2212 x 1672 pixels. Color fundus photograph:
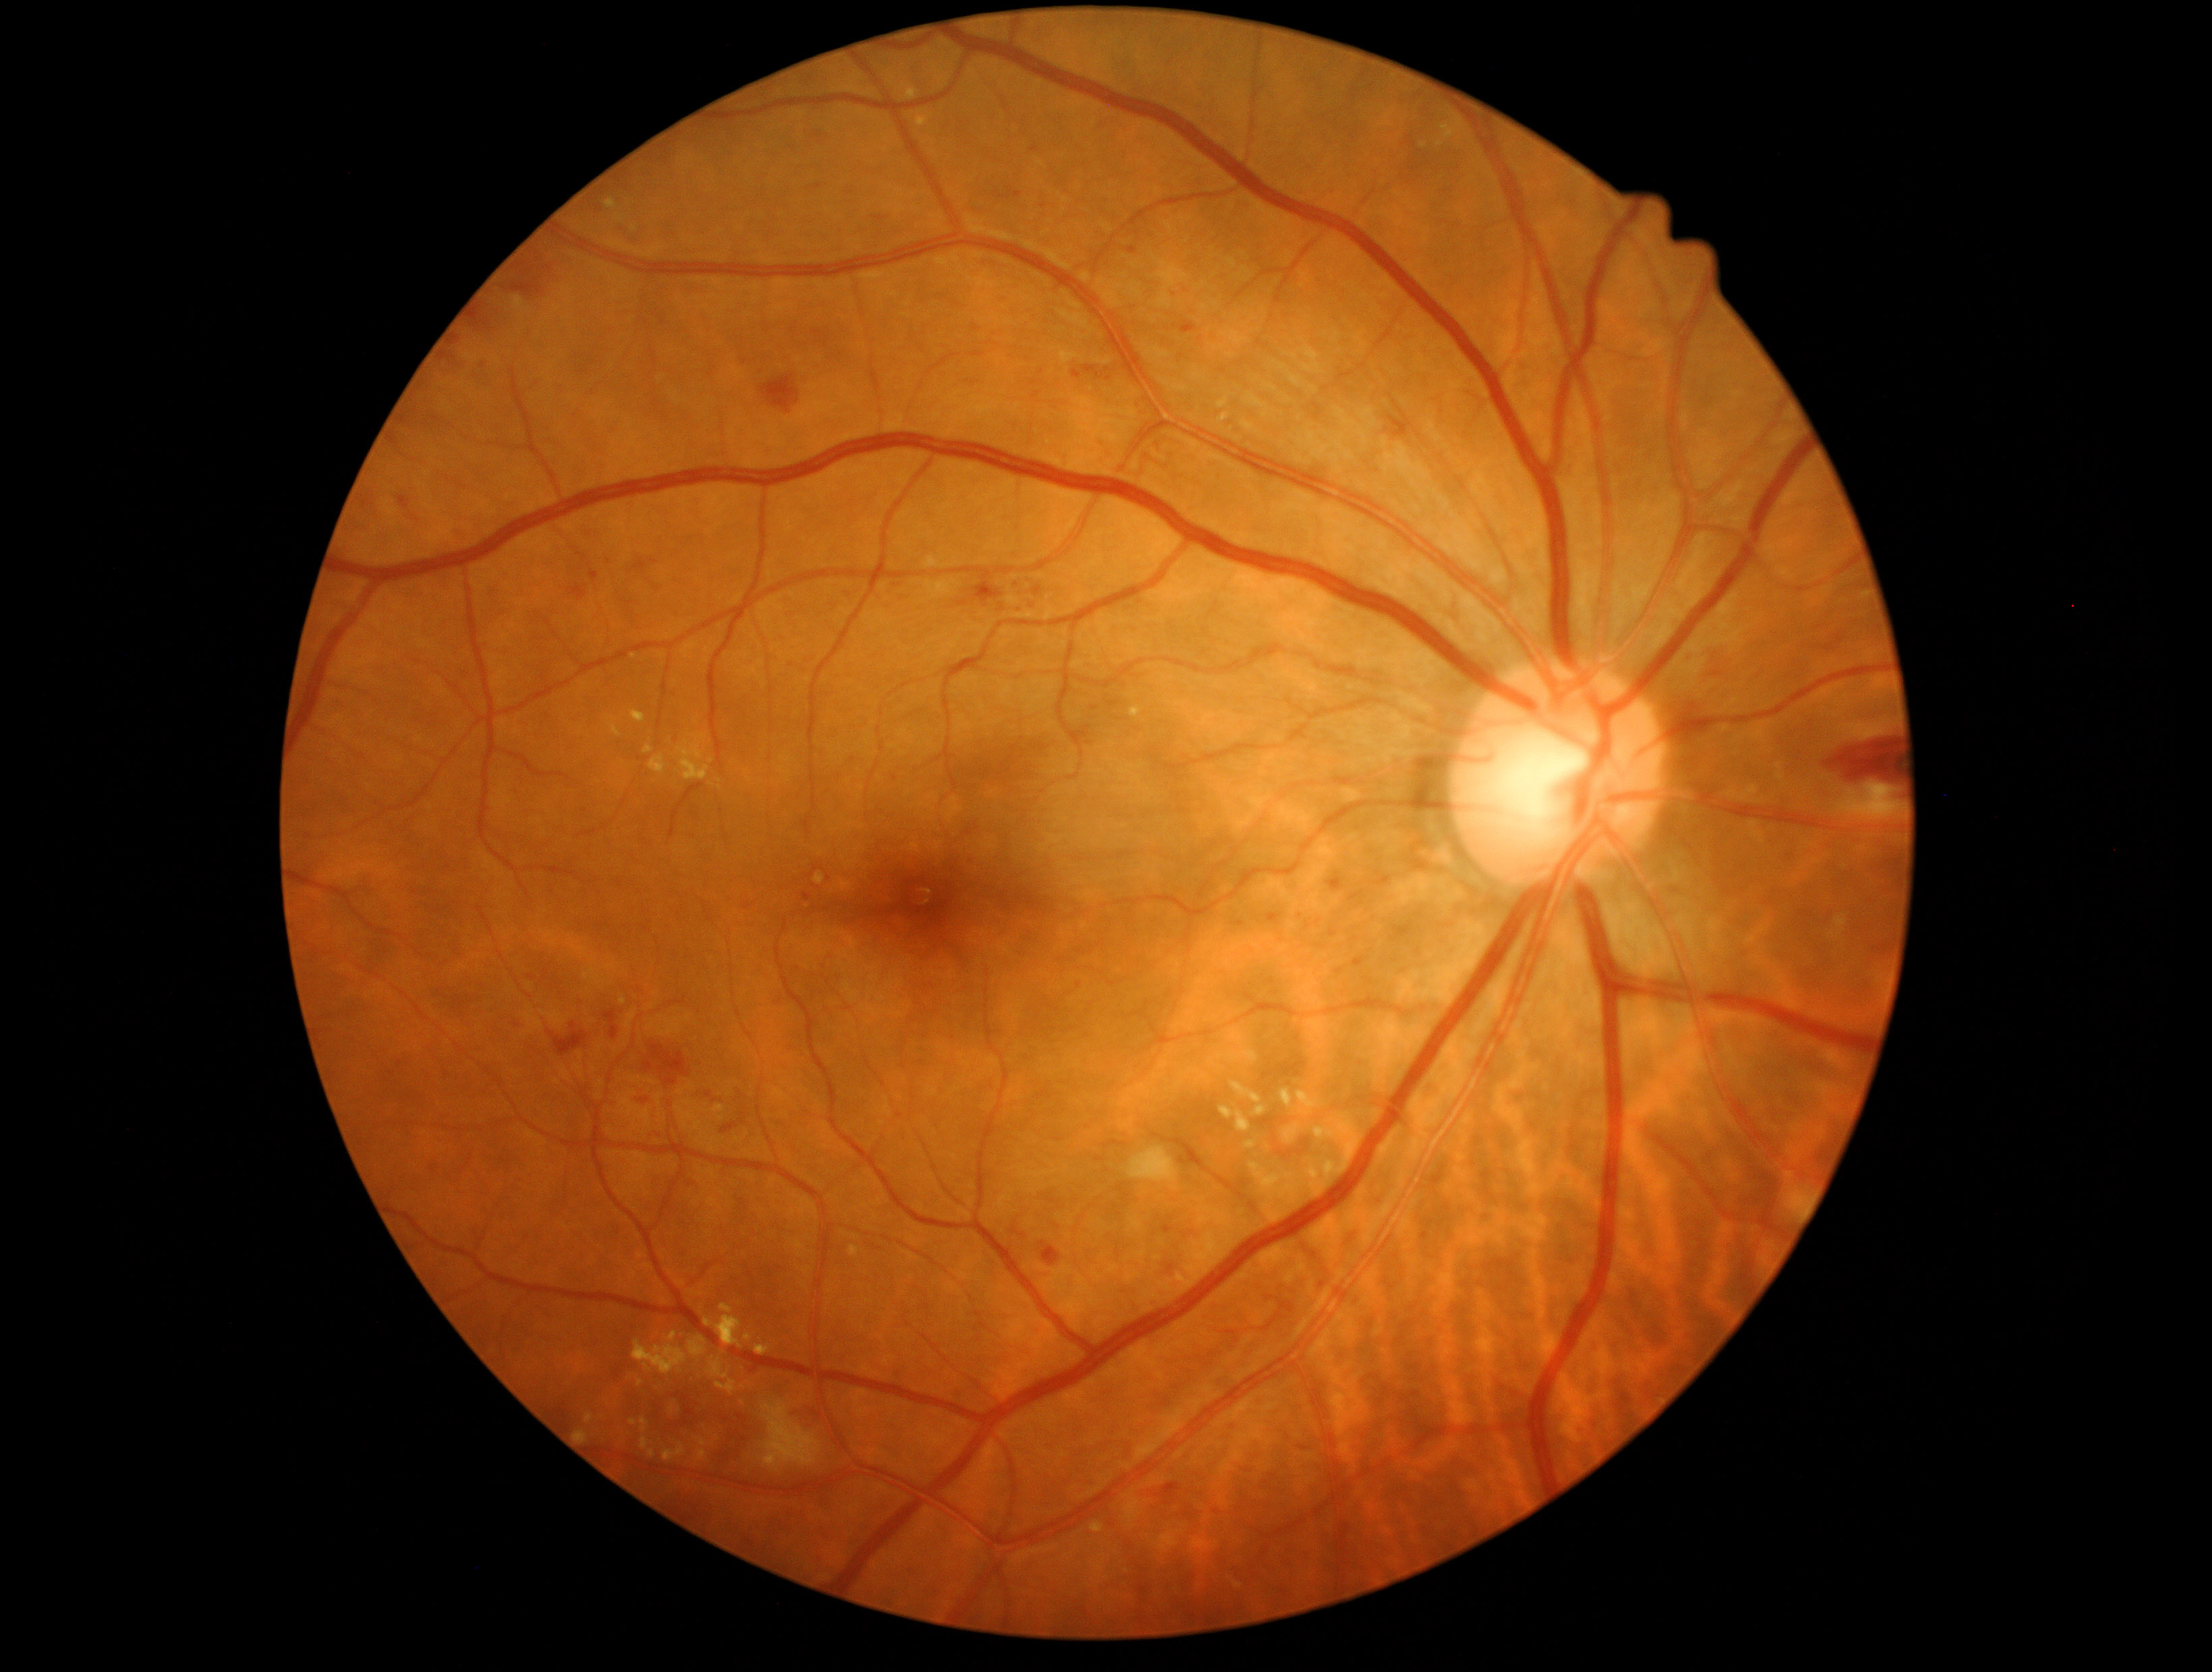

partial: true
dr_grade: 2
lesions:
  se:
    - {"x1": 1130, "y1": 1147, "x2": 1178, "y2": 1183}
    - {"x1": 1831, "y1": 780, "x2": 1905, "y2": 825}
    - {"x1": 760, "y1": 1400, "x2": 822, "y2": 1470}
  he:
    - {"x1": 760, "y1": 376, "x2": 799, "y2": 413}
    - {"x1": 1884, "y1": 791, "x2": 1904, "y2": 799}
    - {"x1": 1389, "y1": 407, "x2": 1413, "y2": 438}
    - {"x1": 400, "y1": 497, "x2": 409, "y2": 508}
    - {"x1": 569, "y1": 585, "x2": 587, "y2": 601}
    - {"x1": 1824, "y1": 740, "x2": 1901, "y2": 781}
    - {"x1": 875, "y1": 216, "x2": 884, "y2": 222}
    - {"x1": 1354, "y1": 957, "x2": 1366, "y2": 966}
    - {"x1": 633, "y1": 1097, "x2": 652, "y2": 1108}
    - {"x1": 1039, "y1": 1241, "x2": 1062, "y2": 1264}
    - {"x1": 970, "y1": 580, "x2": 1004, "y2": 609}
    - {"x1": 644, "y1": 1062, "x2": 653, "y2": 1073}
    - {"x1": 1157, "y1": 1256, "x2": 1182, "y2": 1275}
    - {"x1": 721, "y1": 1123, "x2": 738, "y2": 1133}
  he_small:
    - x=818 y=187
  ex:
    - {"x1": 720, "y1": 1303, "x2": 733, "y2": 1313}
    - {"x1": 613, "y1": 725, "x2": 622, "y2": 737}
    - {"x1": 1246, "y1": 1163, "x2": 1260, "y2": 1171}
    - {"x1": 1219, "y1": 413, "x2": 1231, "y2": 423}
    - {"x1": 641, "y1": 1435, "x2": 651, "y2": 1450}
    - {"x1": 1285, "y1": 1123, "x2": 1304, "y2": 1143}
    - {"x1": 687, "y1": 1336, "x2": 707, "y2": 1360}
    - {"x1": 1131, "y1": 707, "x2": 1142, "y2": 717}
    - {"x1": 902, "y1": 84, "x2": 918, "y2": 100}
    - {"x1": 633, "y1": 1332, "x2": 687, "y2": 1375}
    - {"x1": 574, "y1": 1429, "x2": 589, "y2": 1443}
    - {"x1": 744, "y1": 1333, "x2": 752, "y2": 1341}
    - {"x1": 1220, "y1": 1106, "x2": 1251, "y2": 1132}
    - {"x1": 1314, "y1": 1125, "x2": 1328, "y2": 1140}
  ex_small:
    - x=633 y=1421
    - x=634 y=657
    - x=711 y=761
  ma:
    - {"x1": 1072, "y1": 370, "x2": 1082, "y2": 378}
    - {"x1": 1269, "y1": 914, "x2": 1281, "y2": 923}
    - {"x1": 602, "y1": 558, "x2": 610, "y2": 563}
    - {"x1": 1236, "y1": 922, "x2": 1244, "y2": 926}
    - {"x1": 803, "y1": 892, "x2": 813, "y2": 903}
    - {"x1": 1127, "y1": 247, "x2": 1136, "y2": 254}
    - {"x1": 566, "y1": 1019, "x2": 574, "y2": 1027}
    - {"x1": 1165, "y1": 1225, "x2": 1174, "y2": 1233}
  ma_small:
    - x=1034 y=149
    - x=708 y=1094
    - x=482 y=364
    - x=1109 y=379
    - x=1021 y=608
    - x=1017 y=194
    - x=1173 y=294
    - x=1078 y=985
    - x=532 y=977
    - x=1099 y=375